CFP. 848 by 848 pixels. Graded on the modified Davis scale:
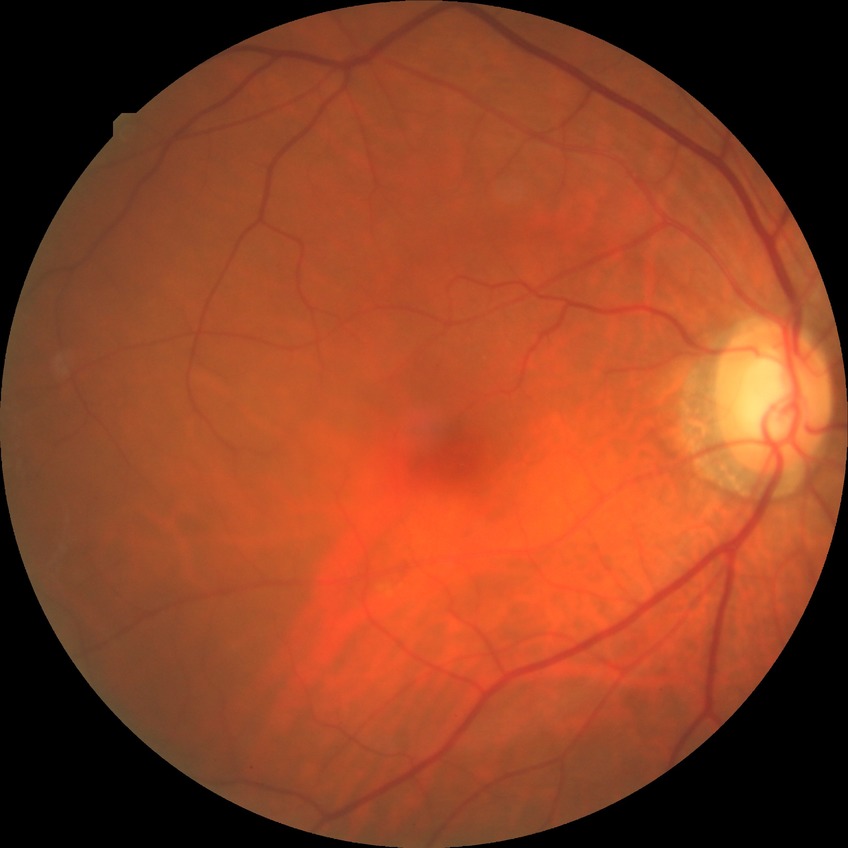
diabetic retinopathy severity = no diabetic retinopathy.